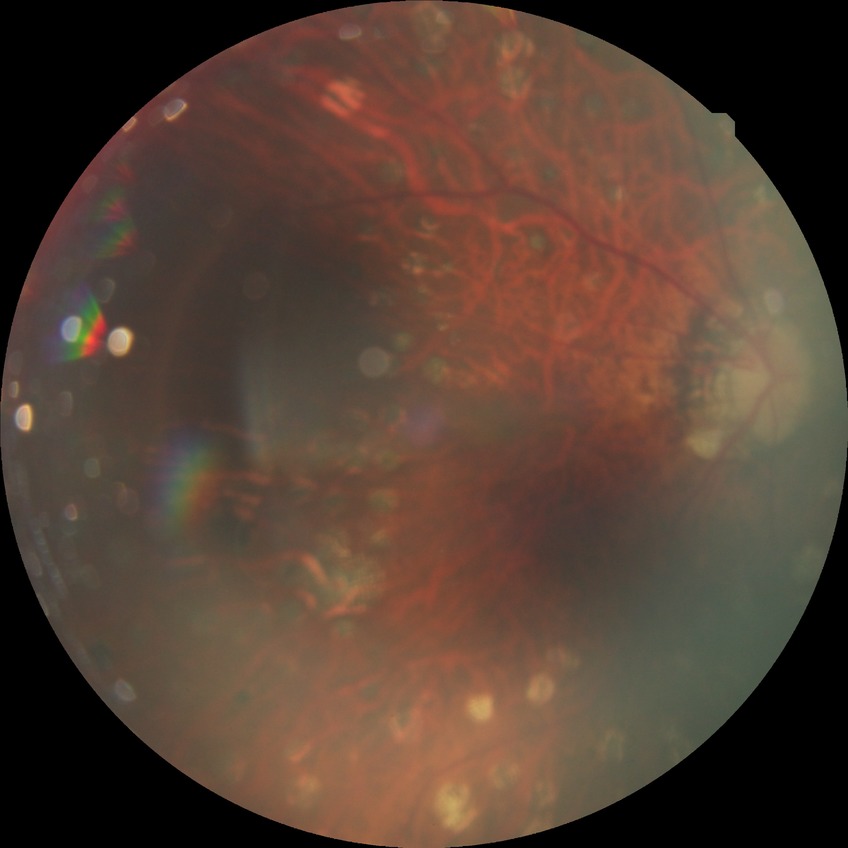
Davis grading is proliferative diabetic retinopathy.